45 degree fundus photograph; 848 by 848 pixels; retinal fundus photograph: 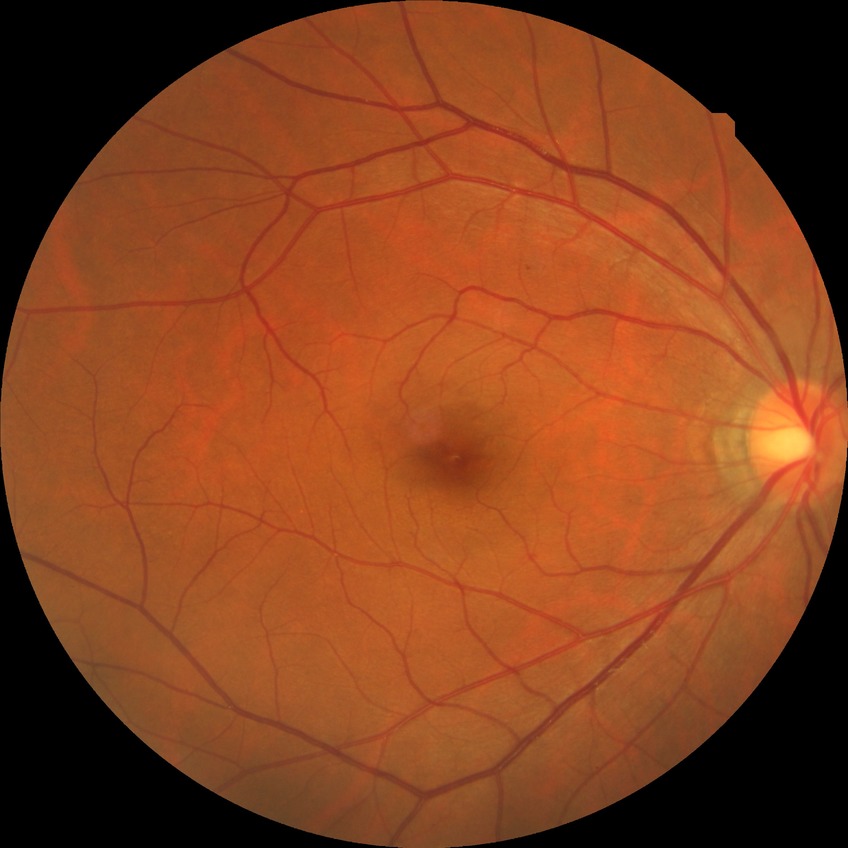 Diabetic retinopathy (DR) is NDR (no diabetic retinopathy).